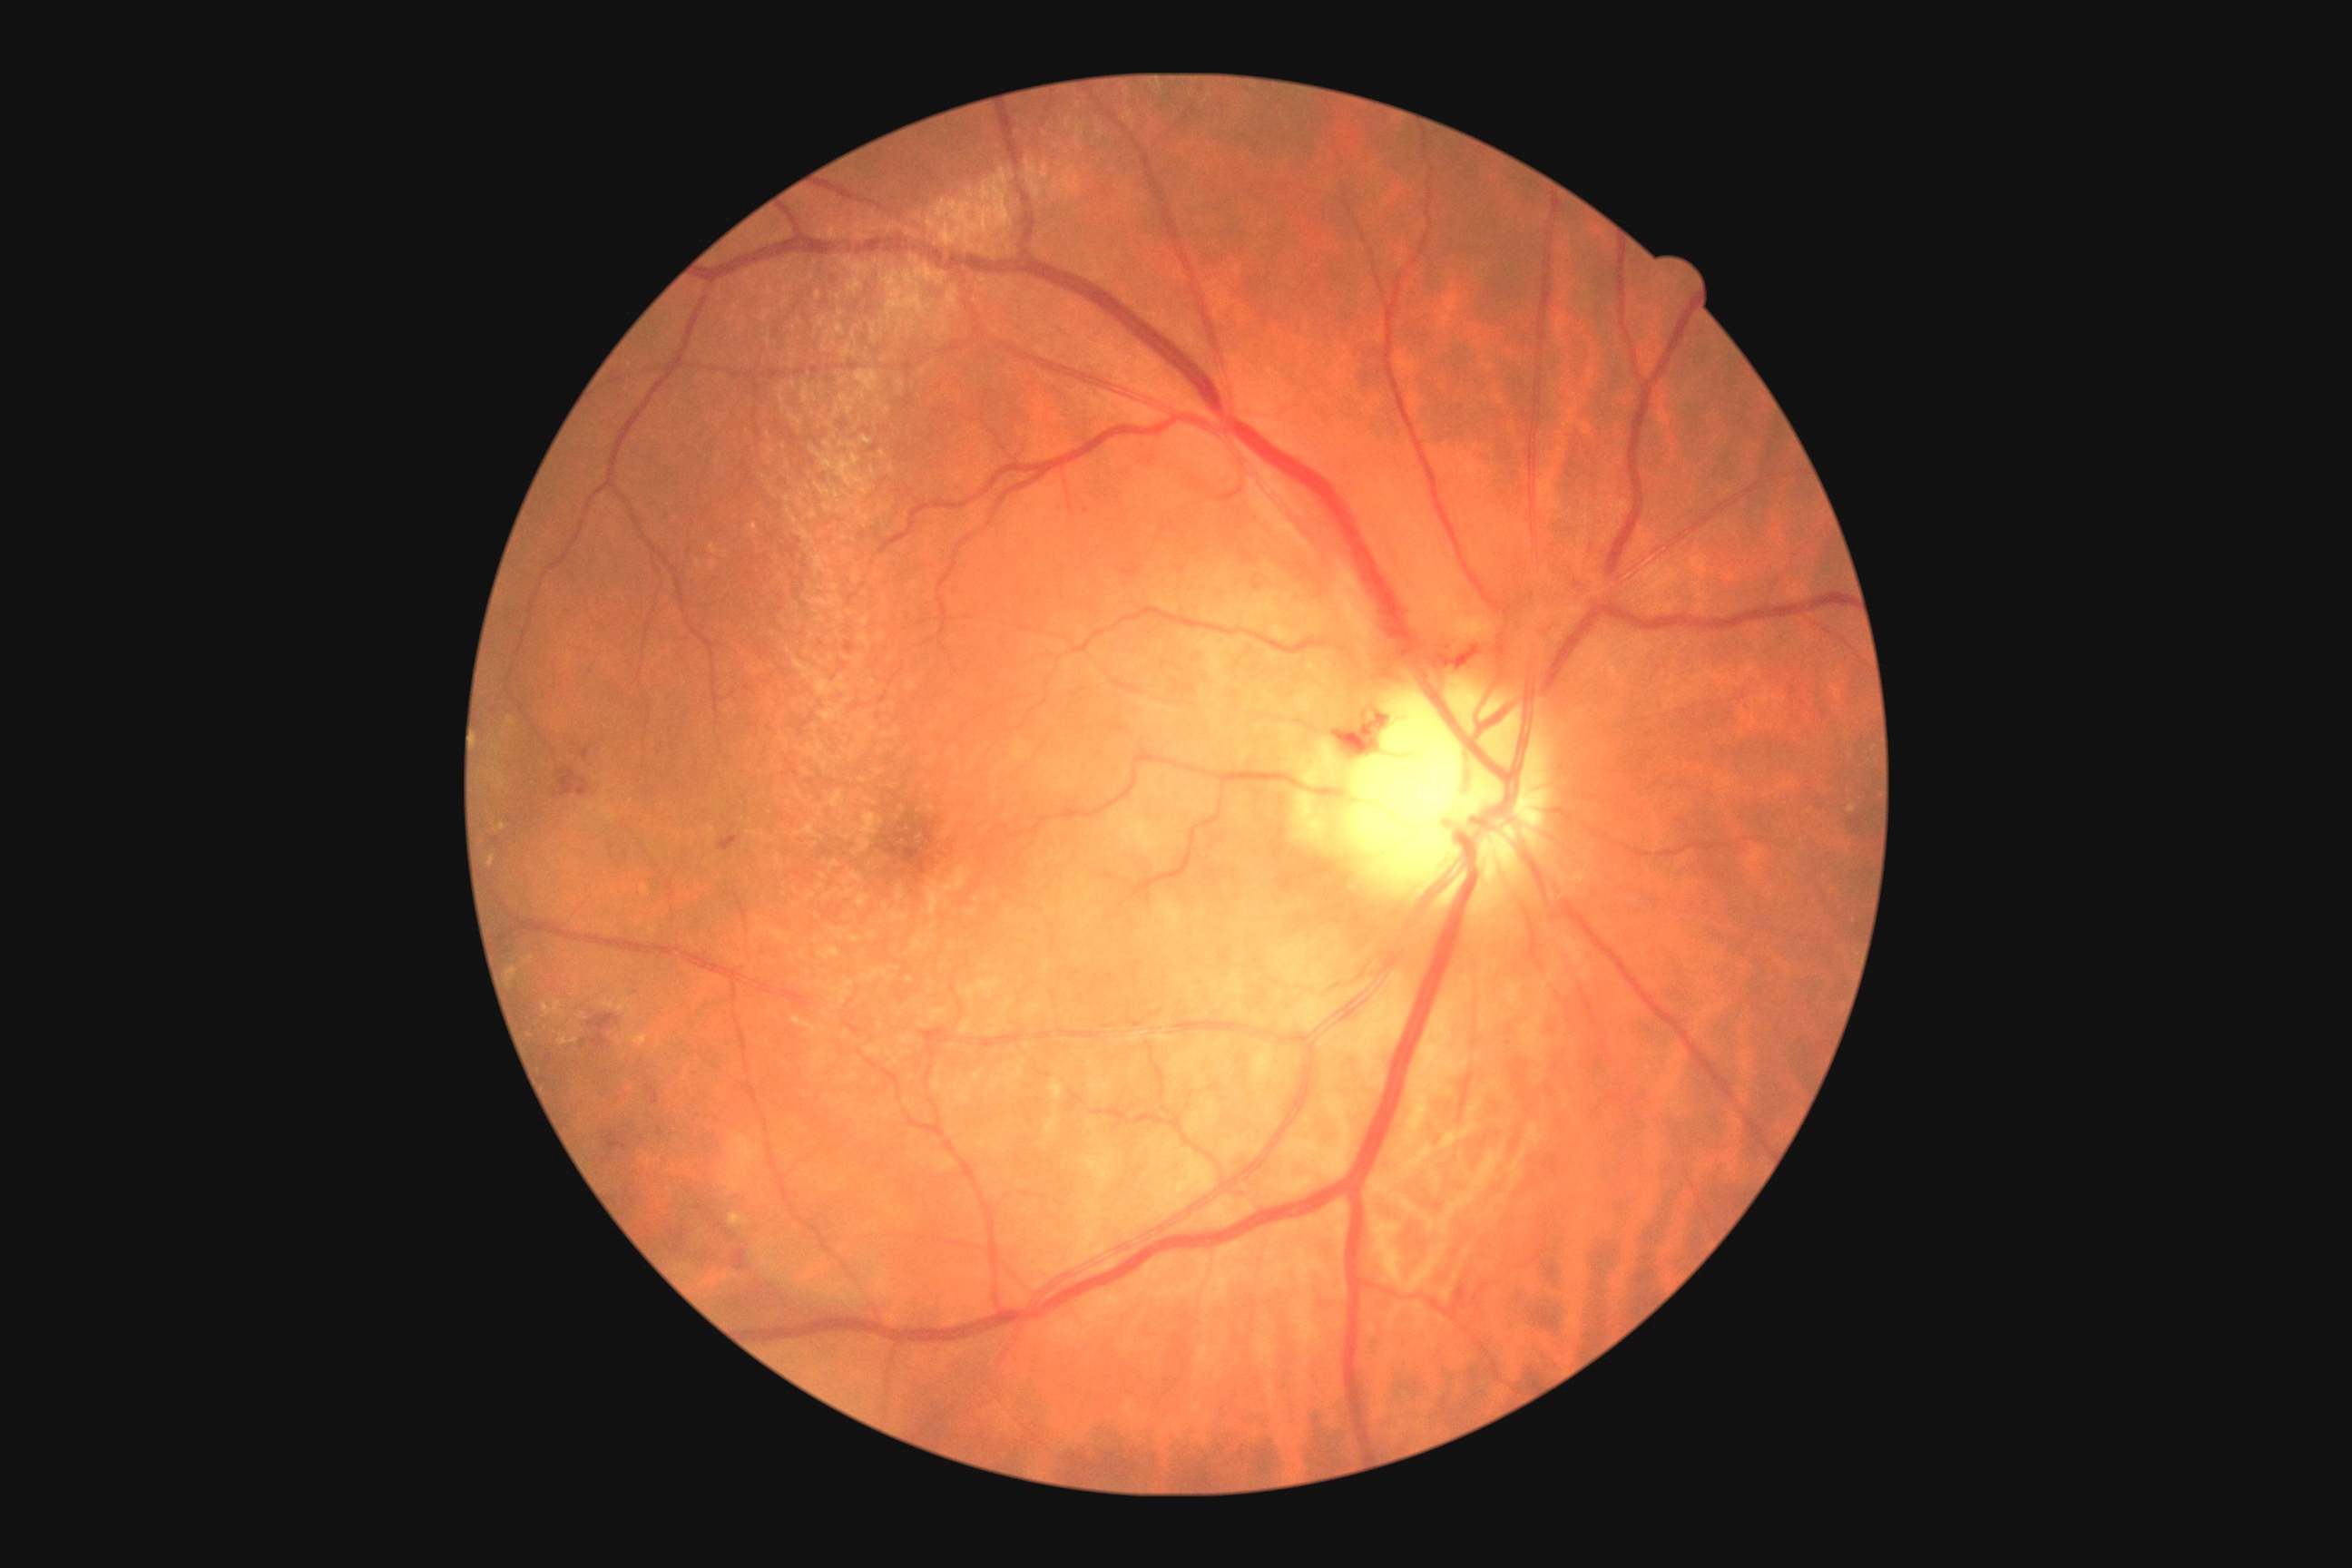

DR grade=2/4.